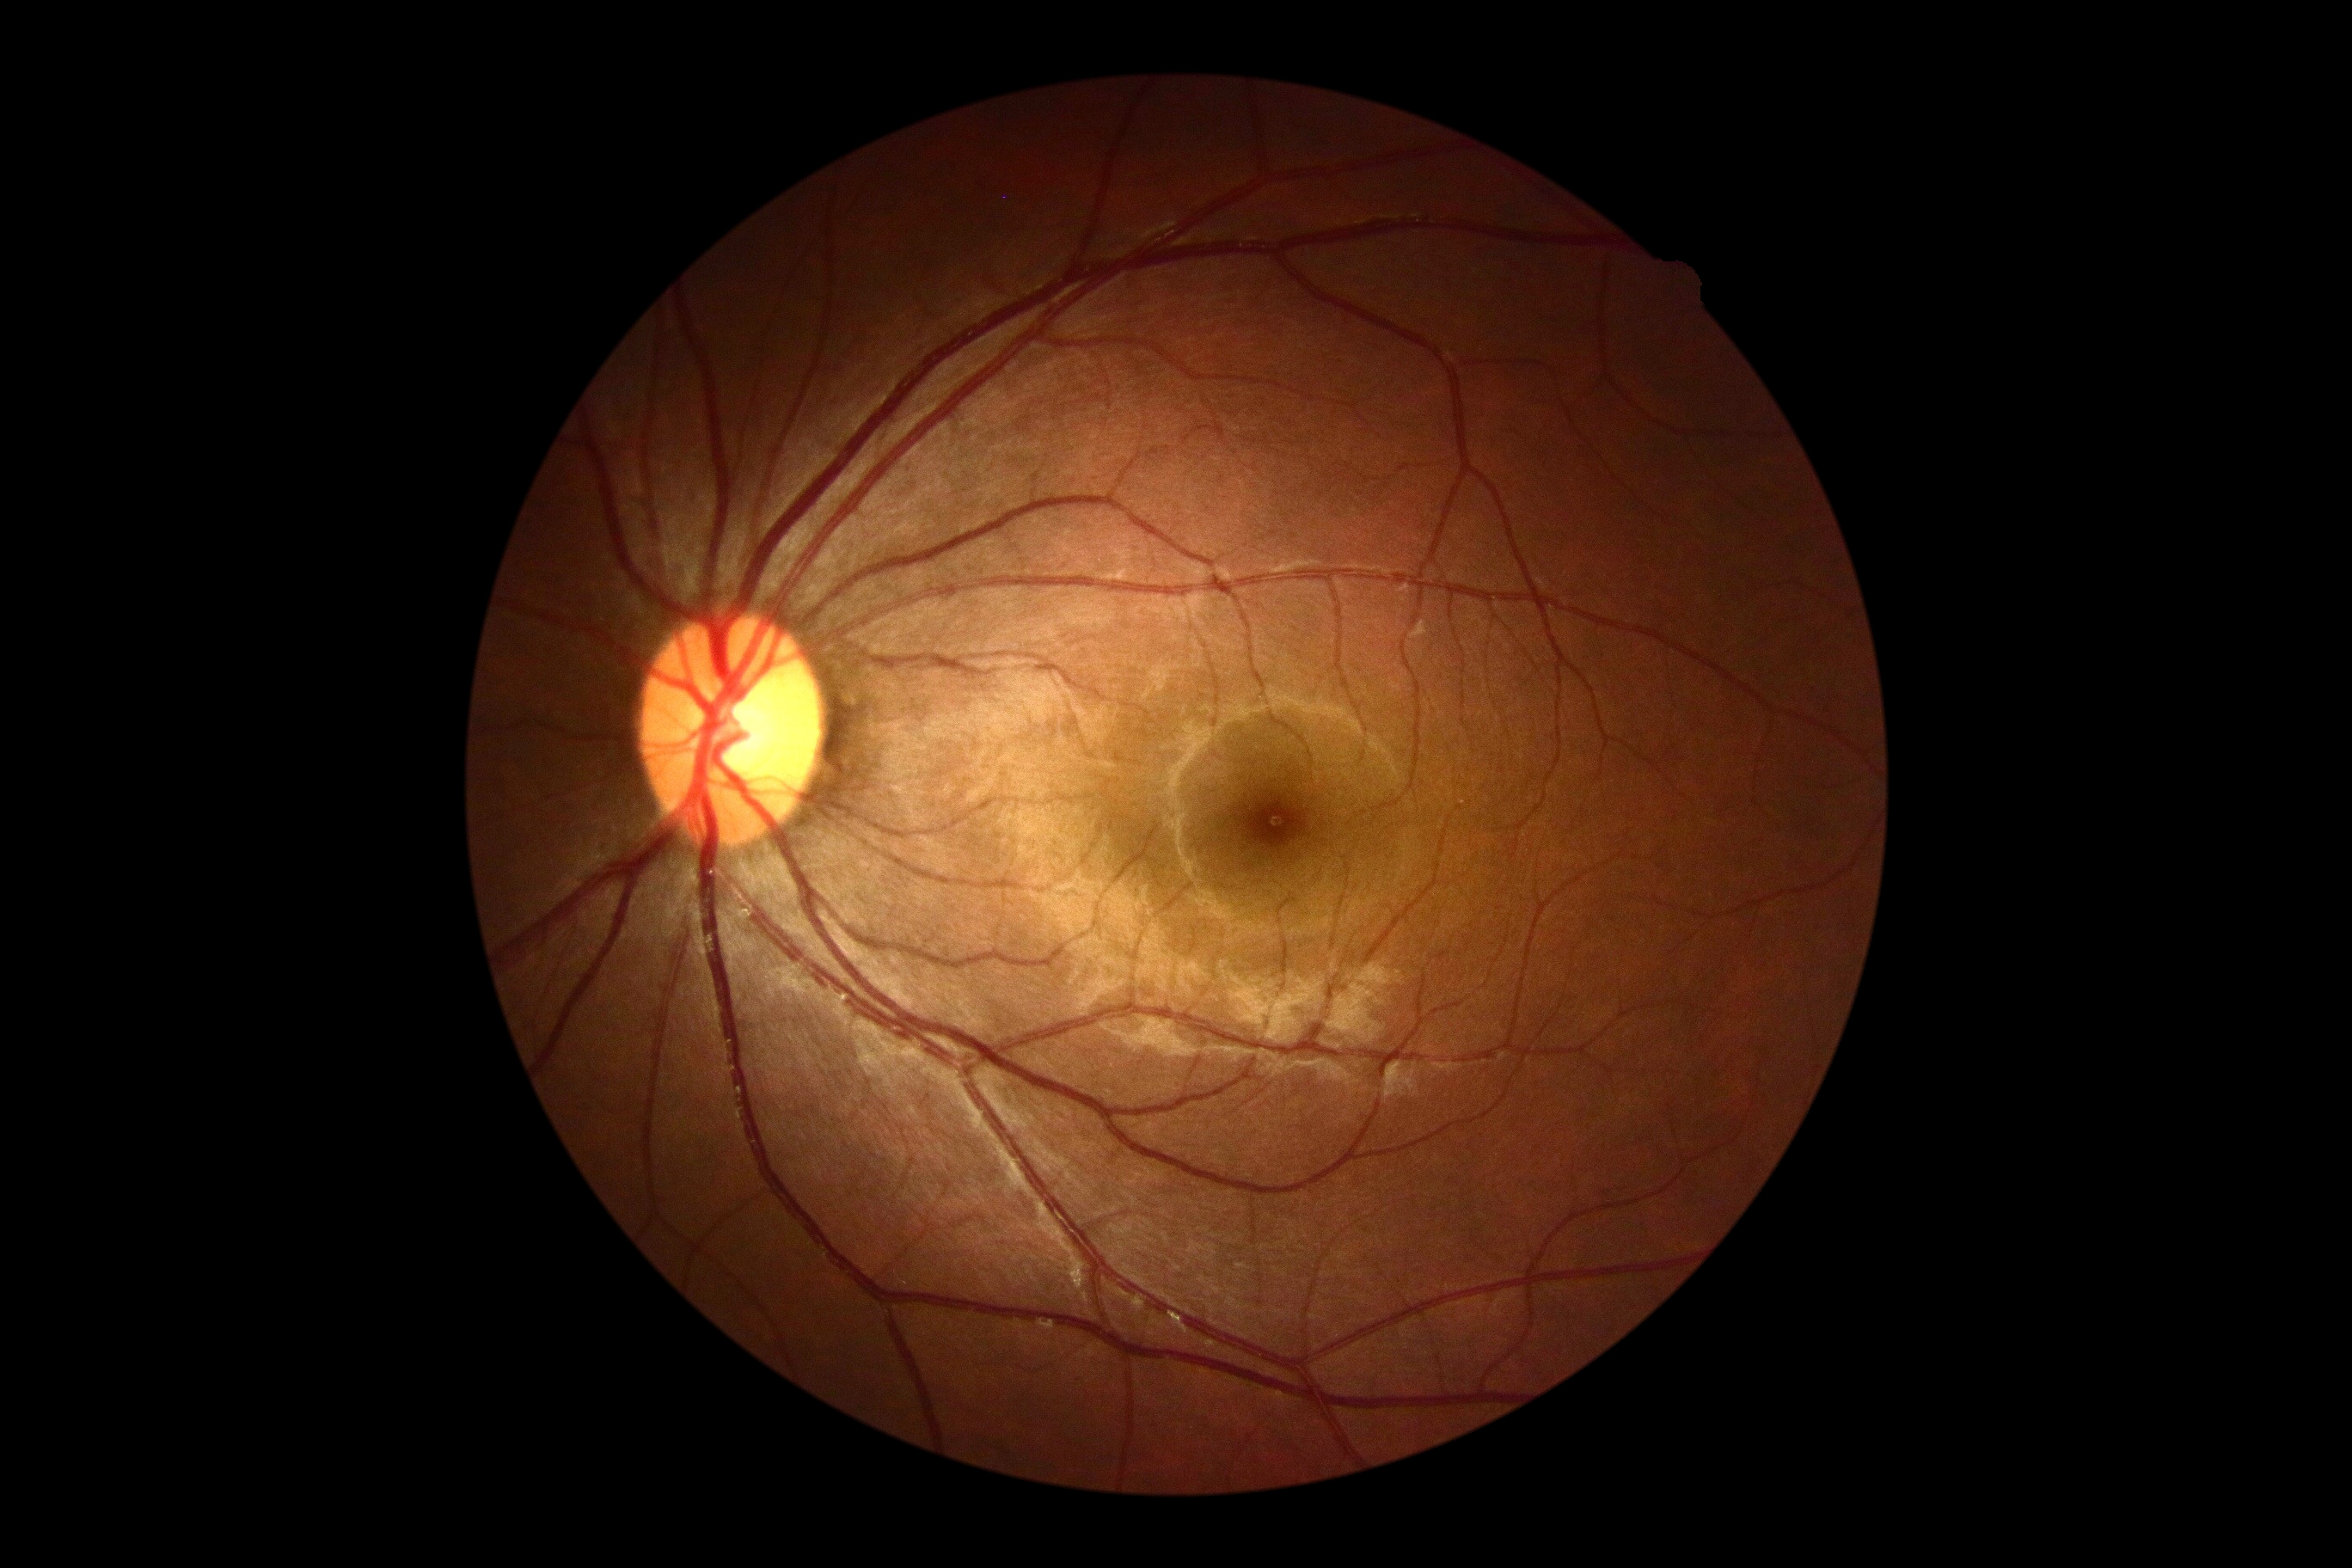 No apparent diabetic retinopathy.
DR stage is no apparent diabetic retinopathy (grade 0).